848 x 848 pixels; modified Davis grading: 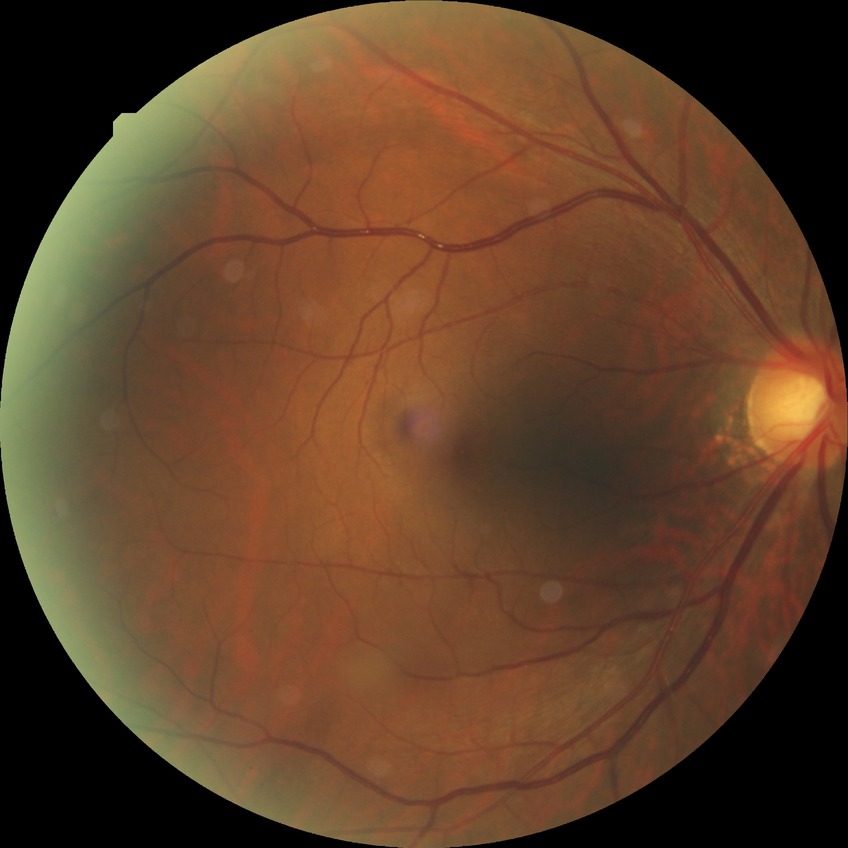

{
  "davis_grade": "no diabetic retinopathy (NDR)"
}